Graded on the modified Davis scale — 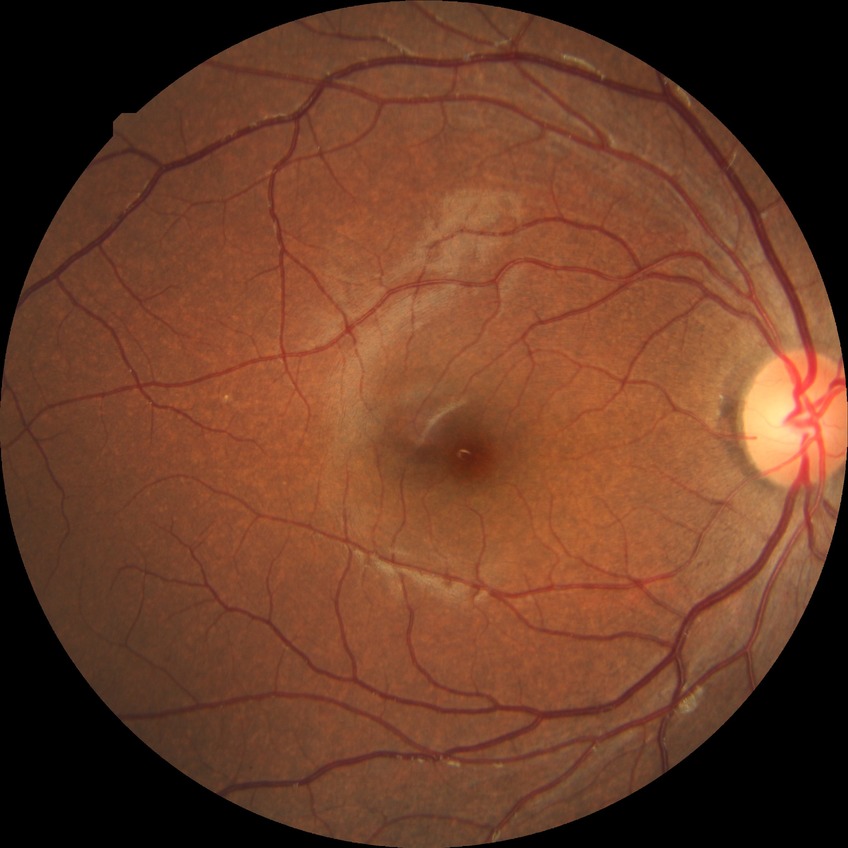
Retinopathy stage: no diabetic retinopathy.